CFP; FOV: 45 degrees: 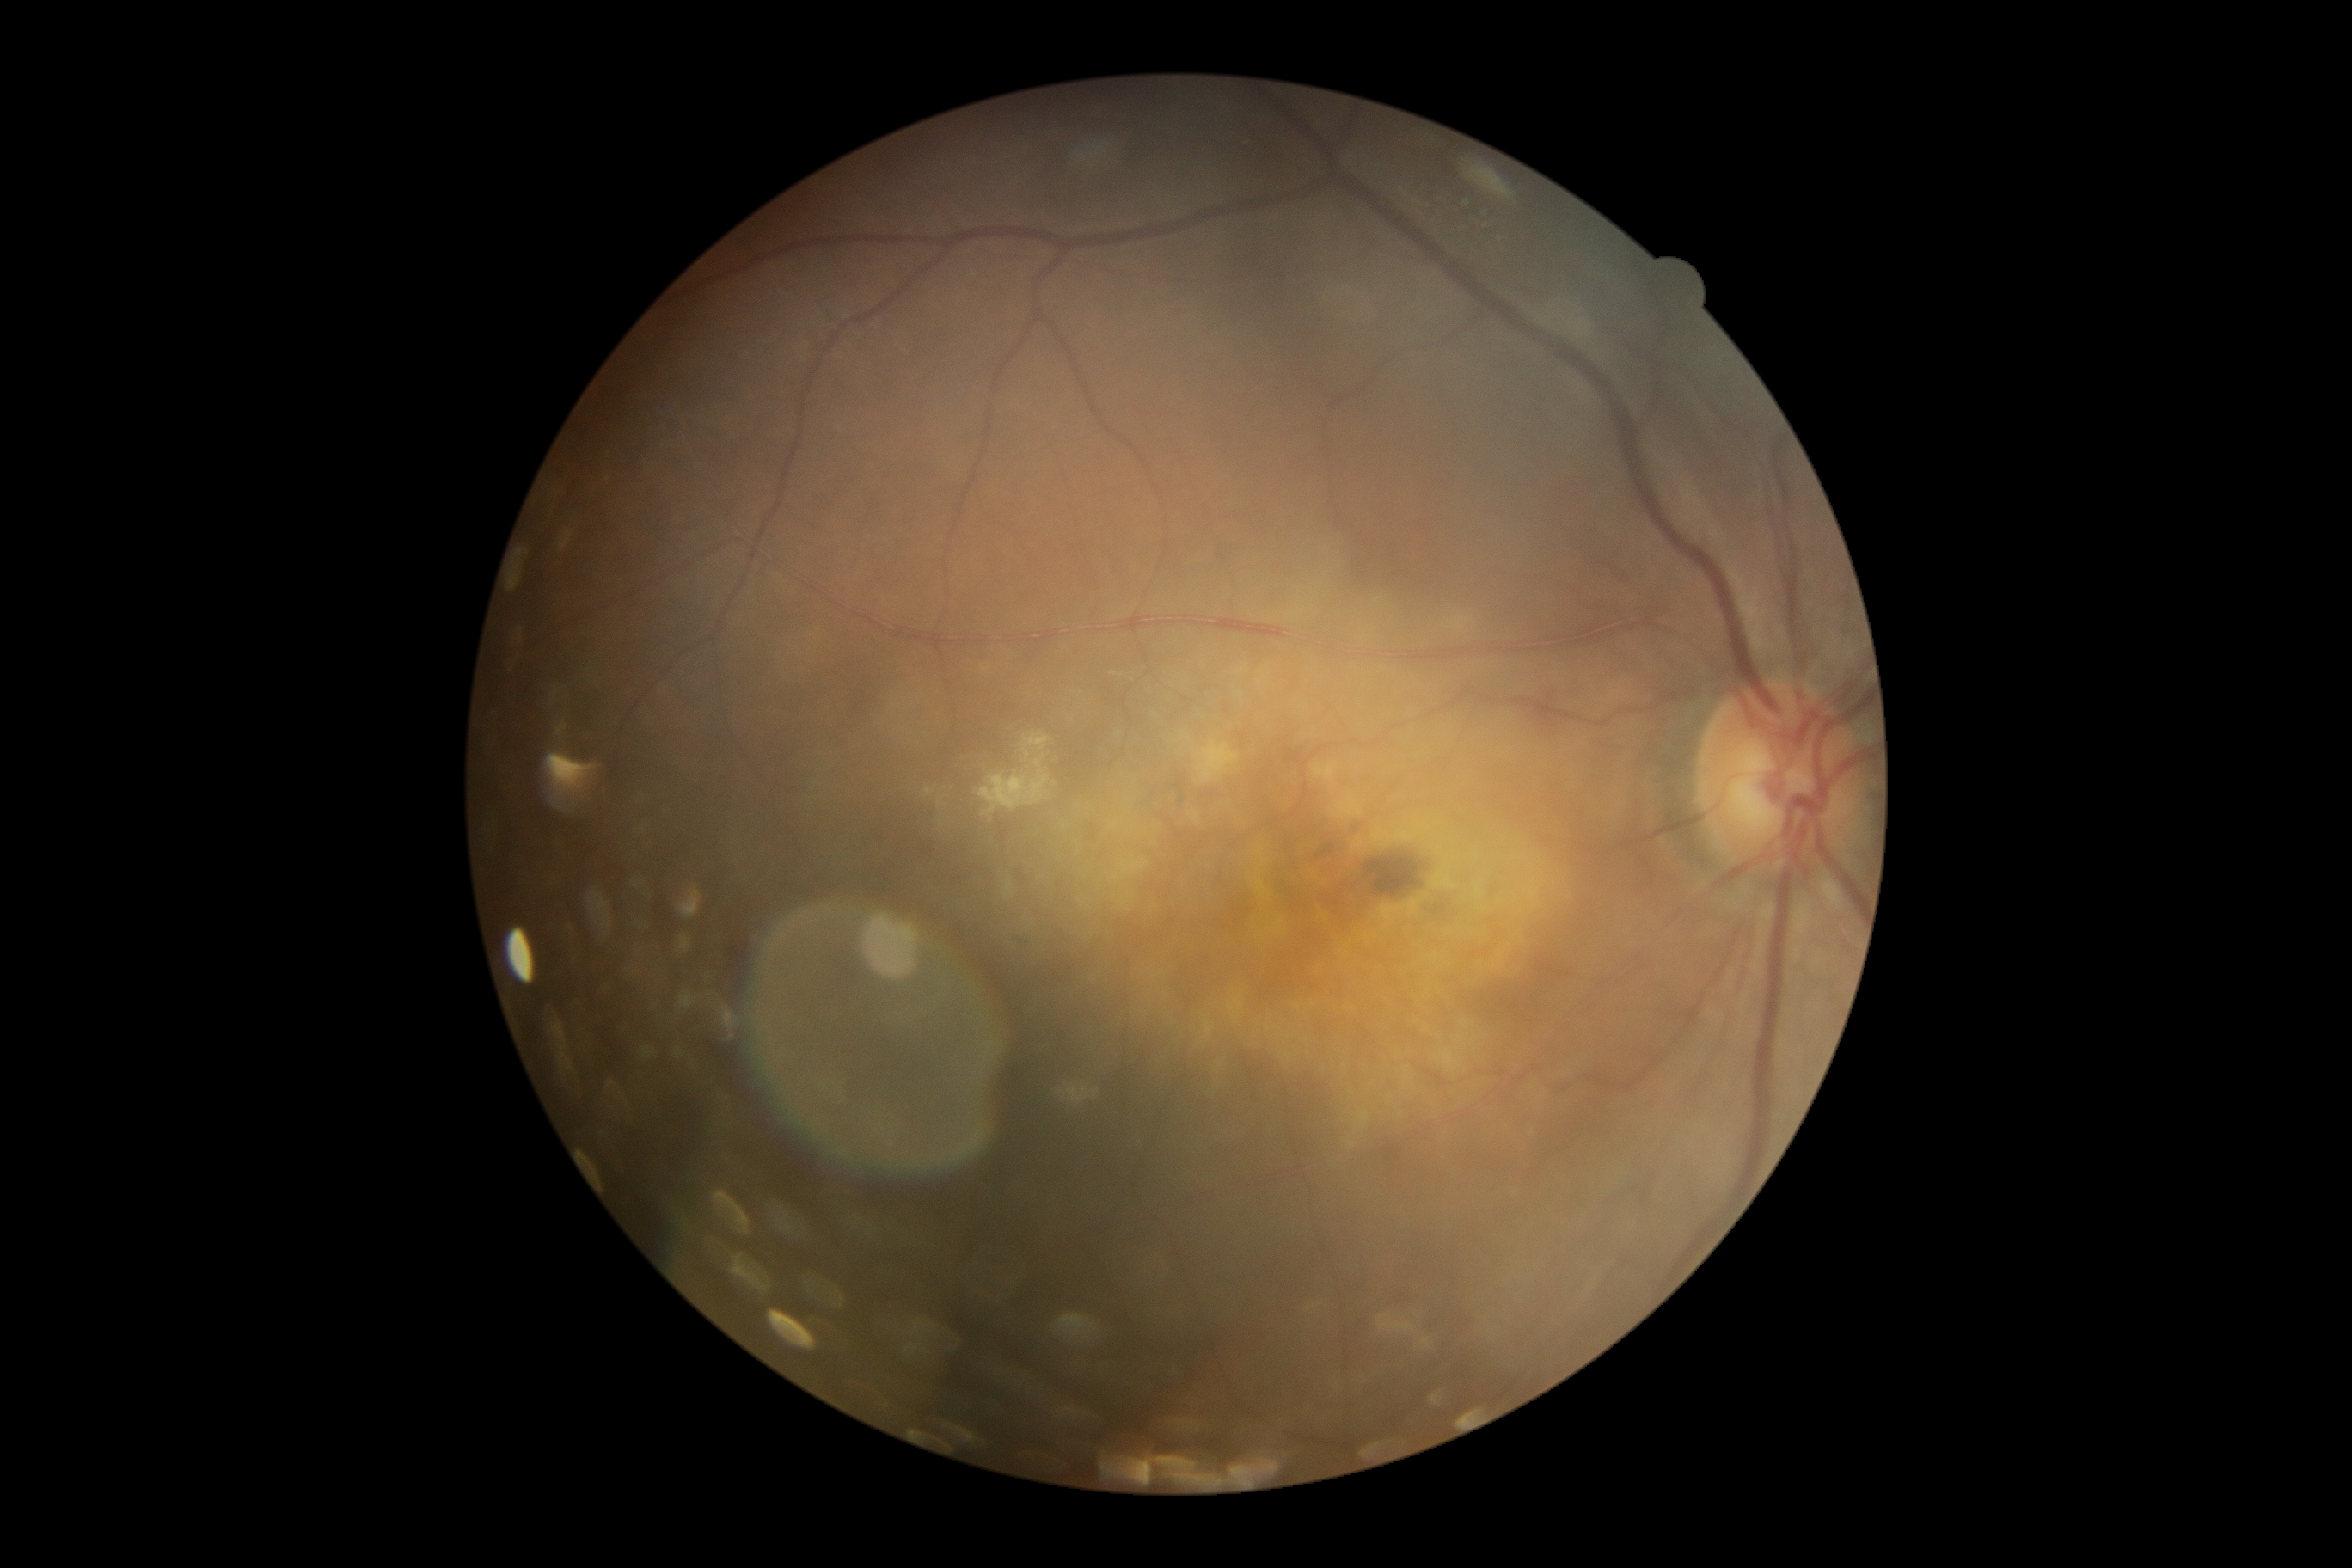 Diabetic retinopathy (DR) is moderate NPDR (grade 2). The retinopathy is classified as non-proliferative diabetic retinopathy.